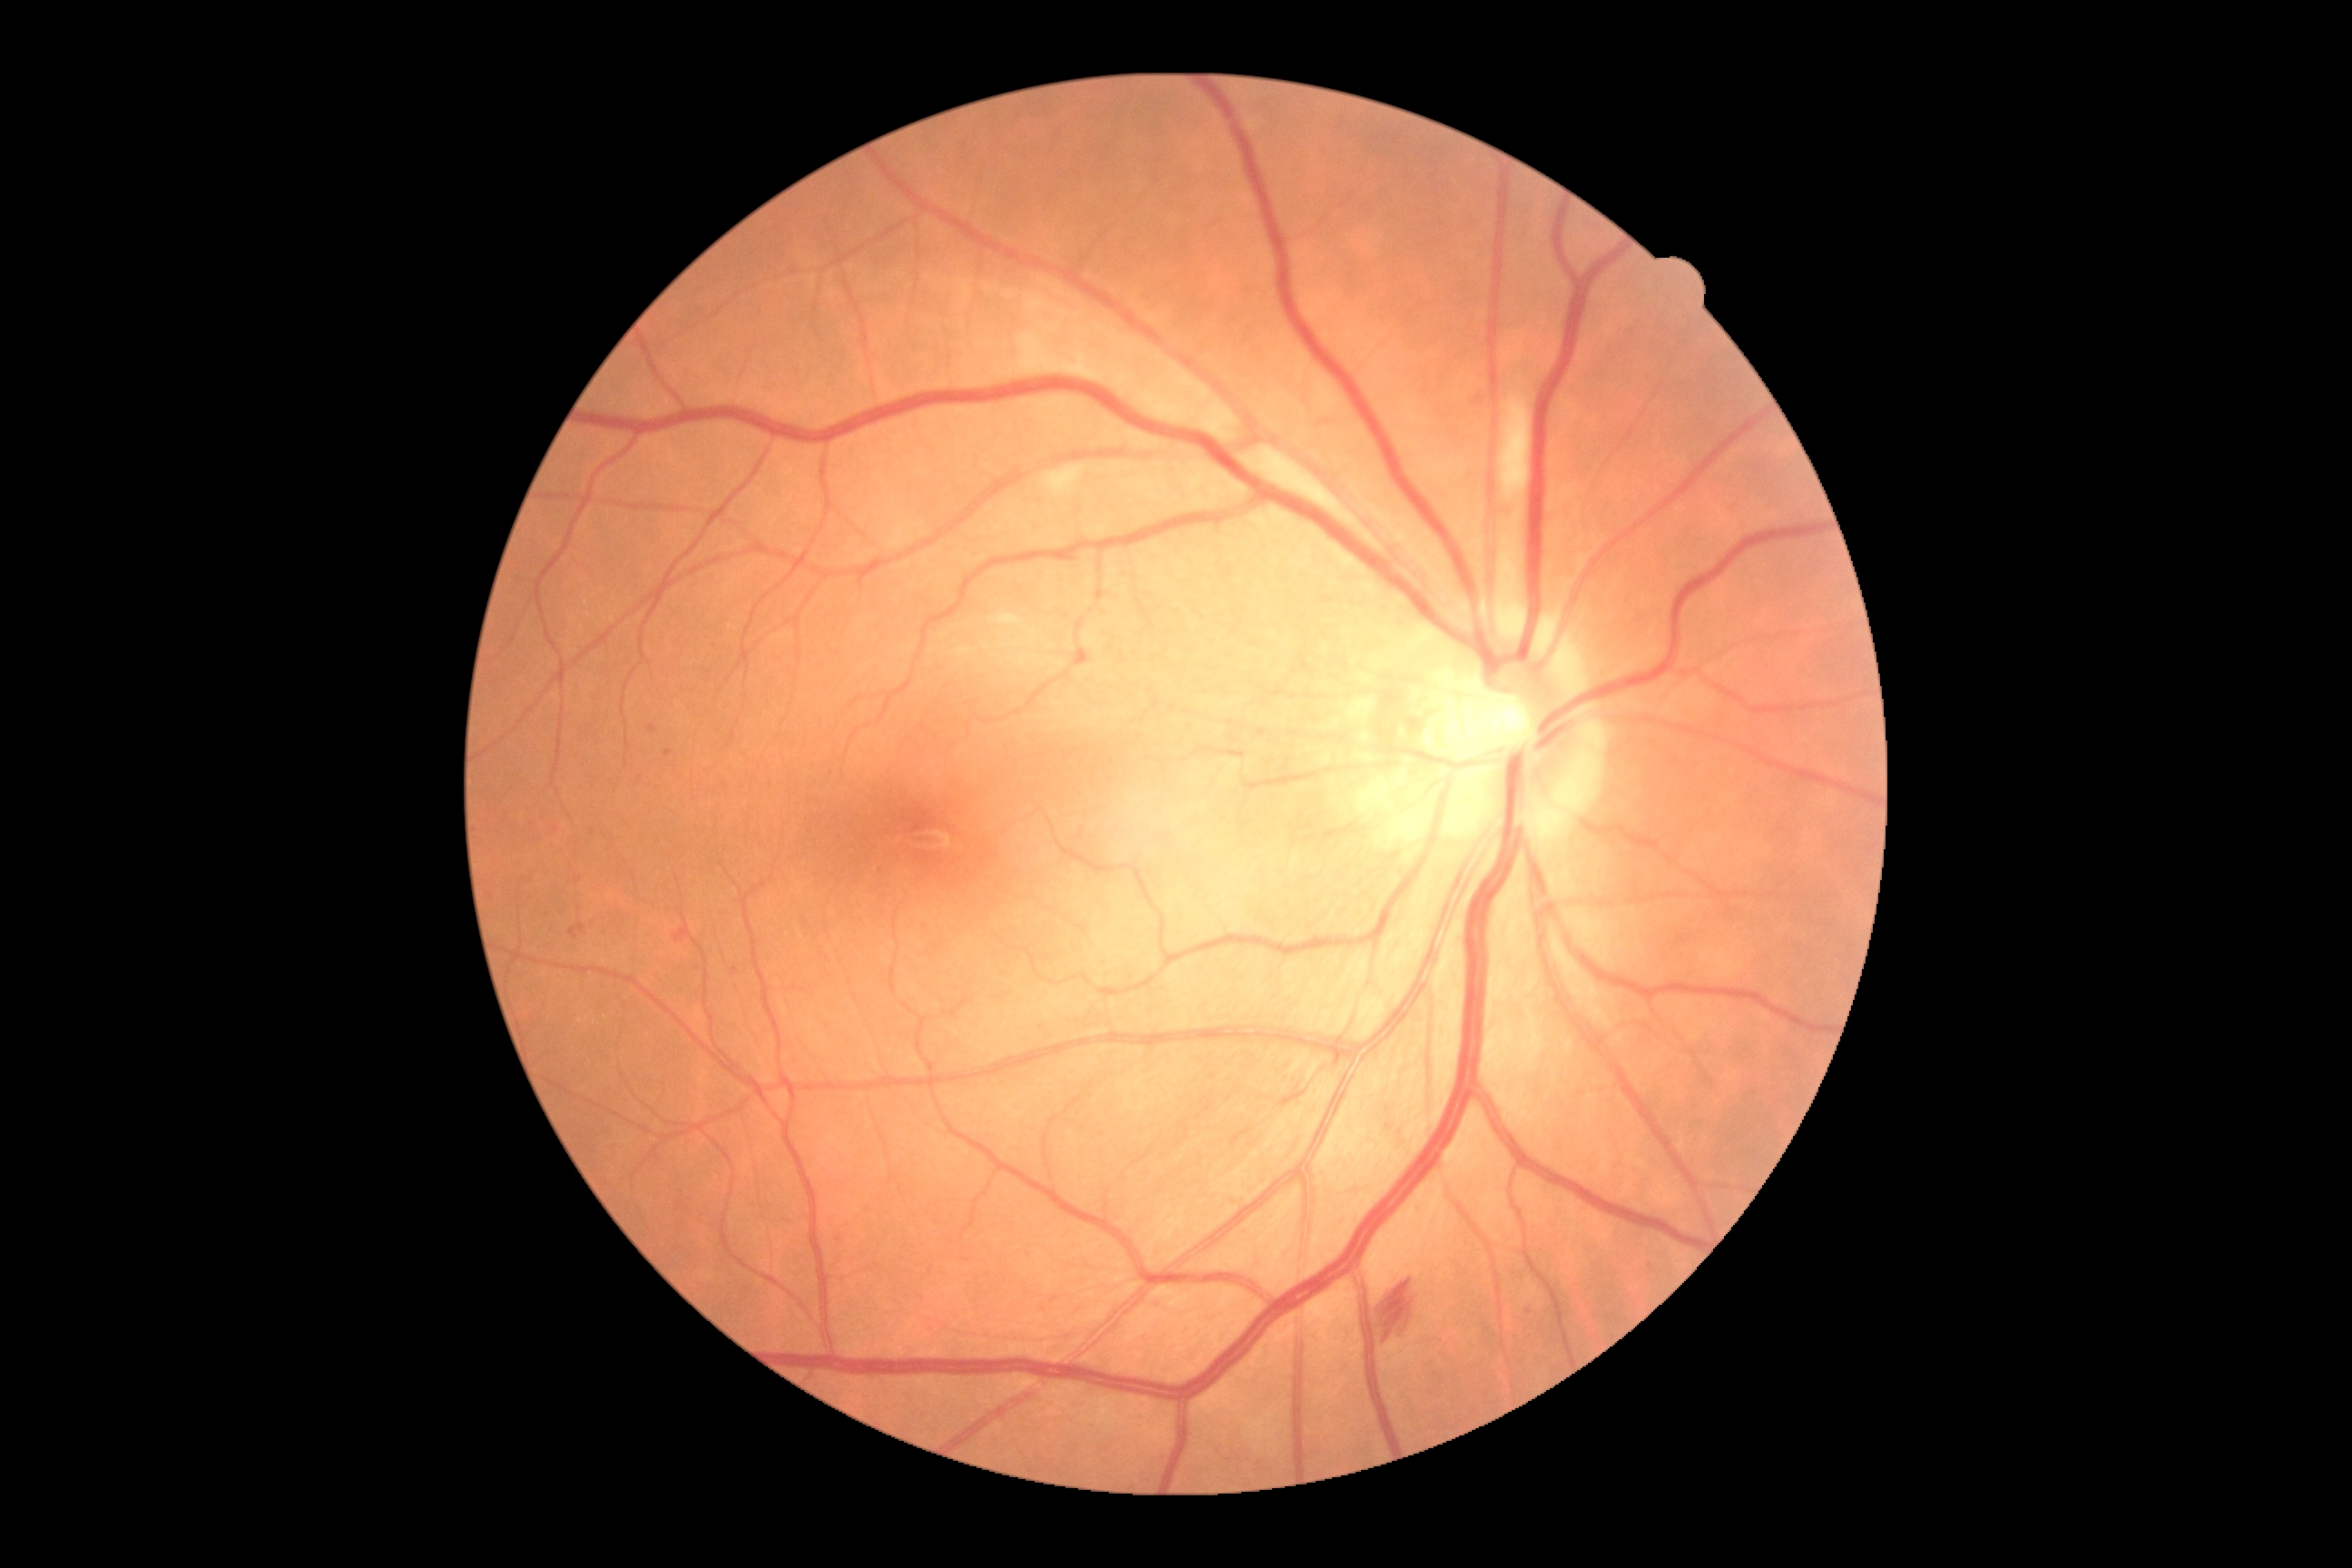
DR severity: grade 2.